Handheld portable fundus camera image — 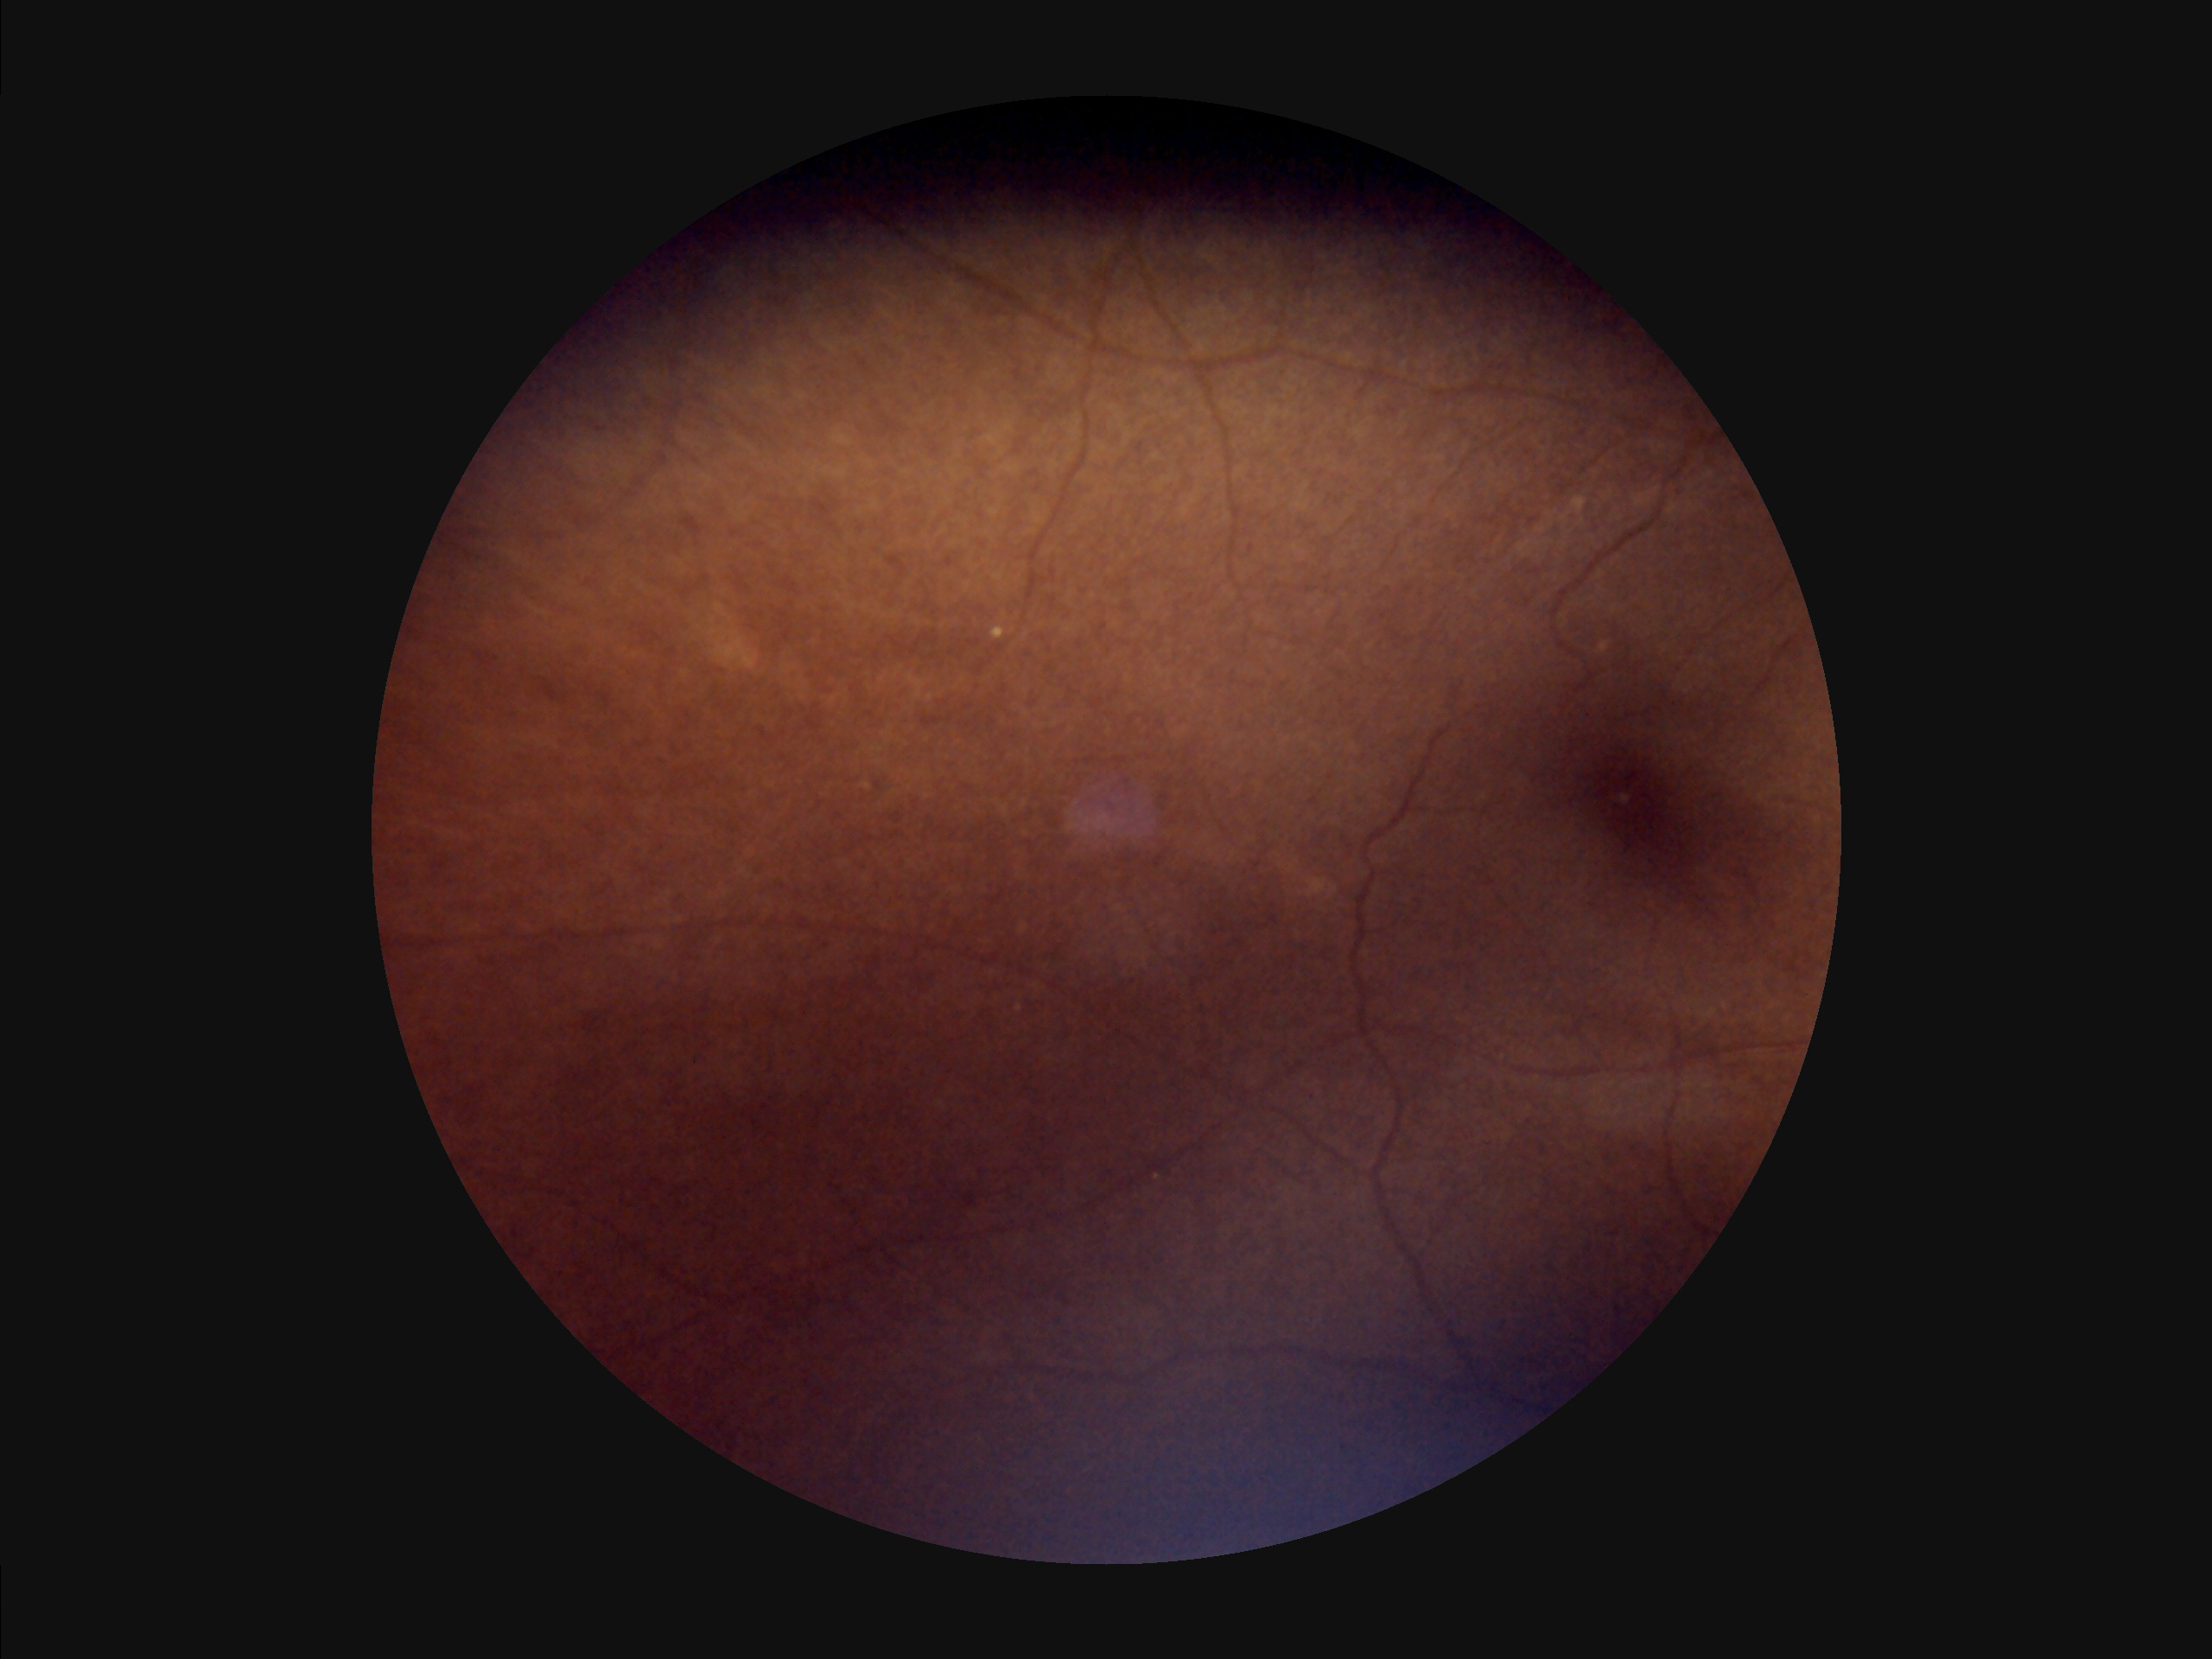 Contrast: poor | Overall image quality: suboptimal | Focus: out of focus | Illumination: suboptimal.